Natus RetCam Envision, 130° FOV. Pediatric retinal photograph (wide-field): 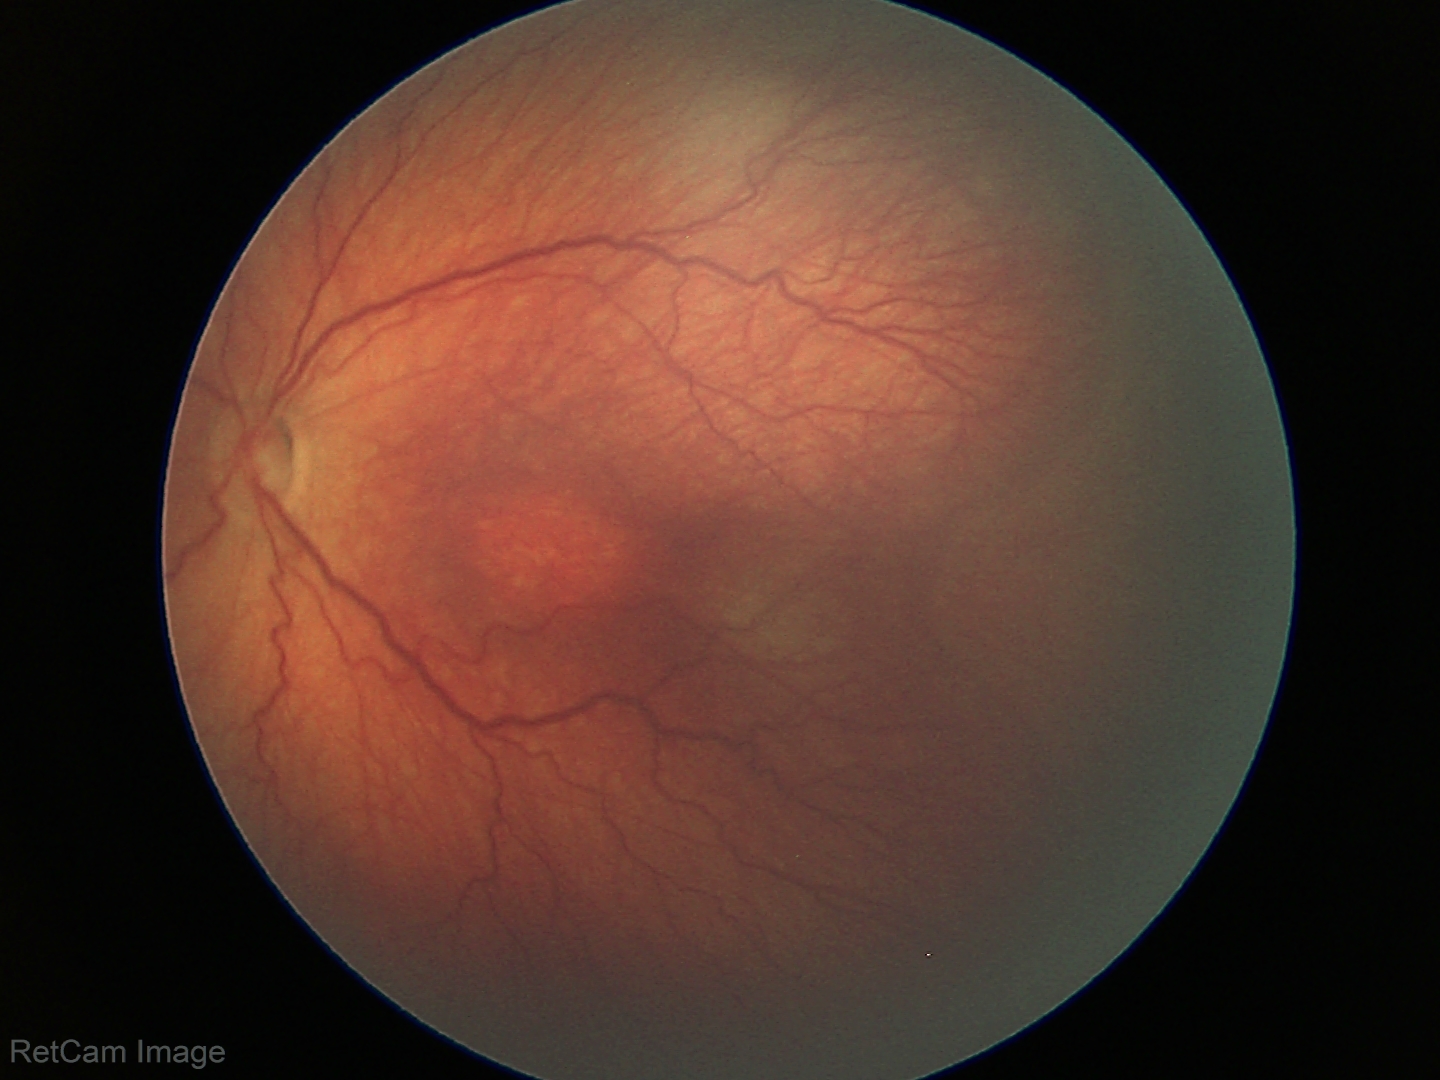
Screening series with retinopathy of prematurity stage 3.